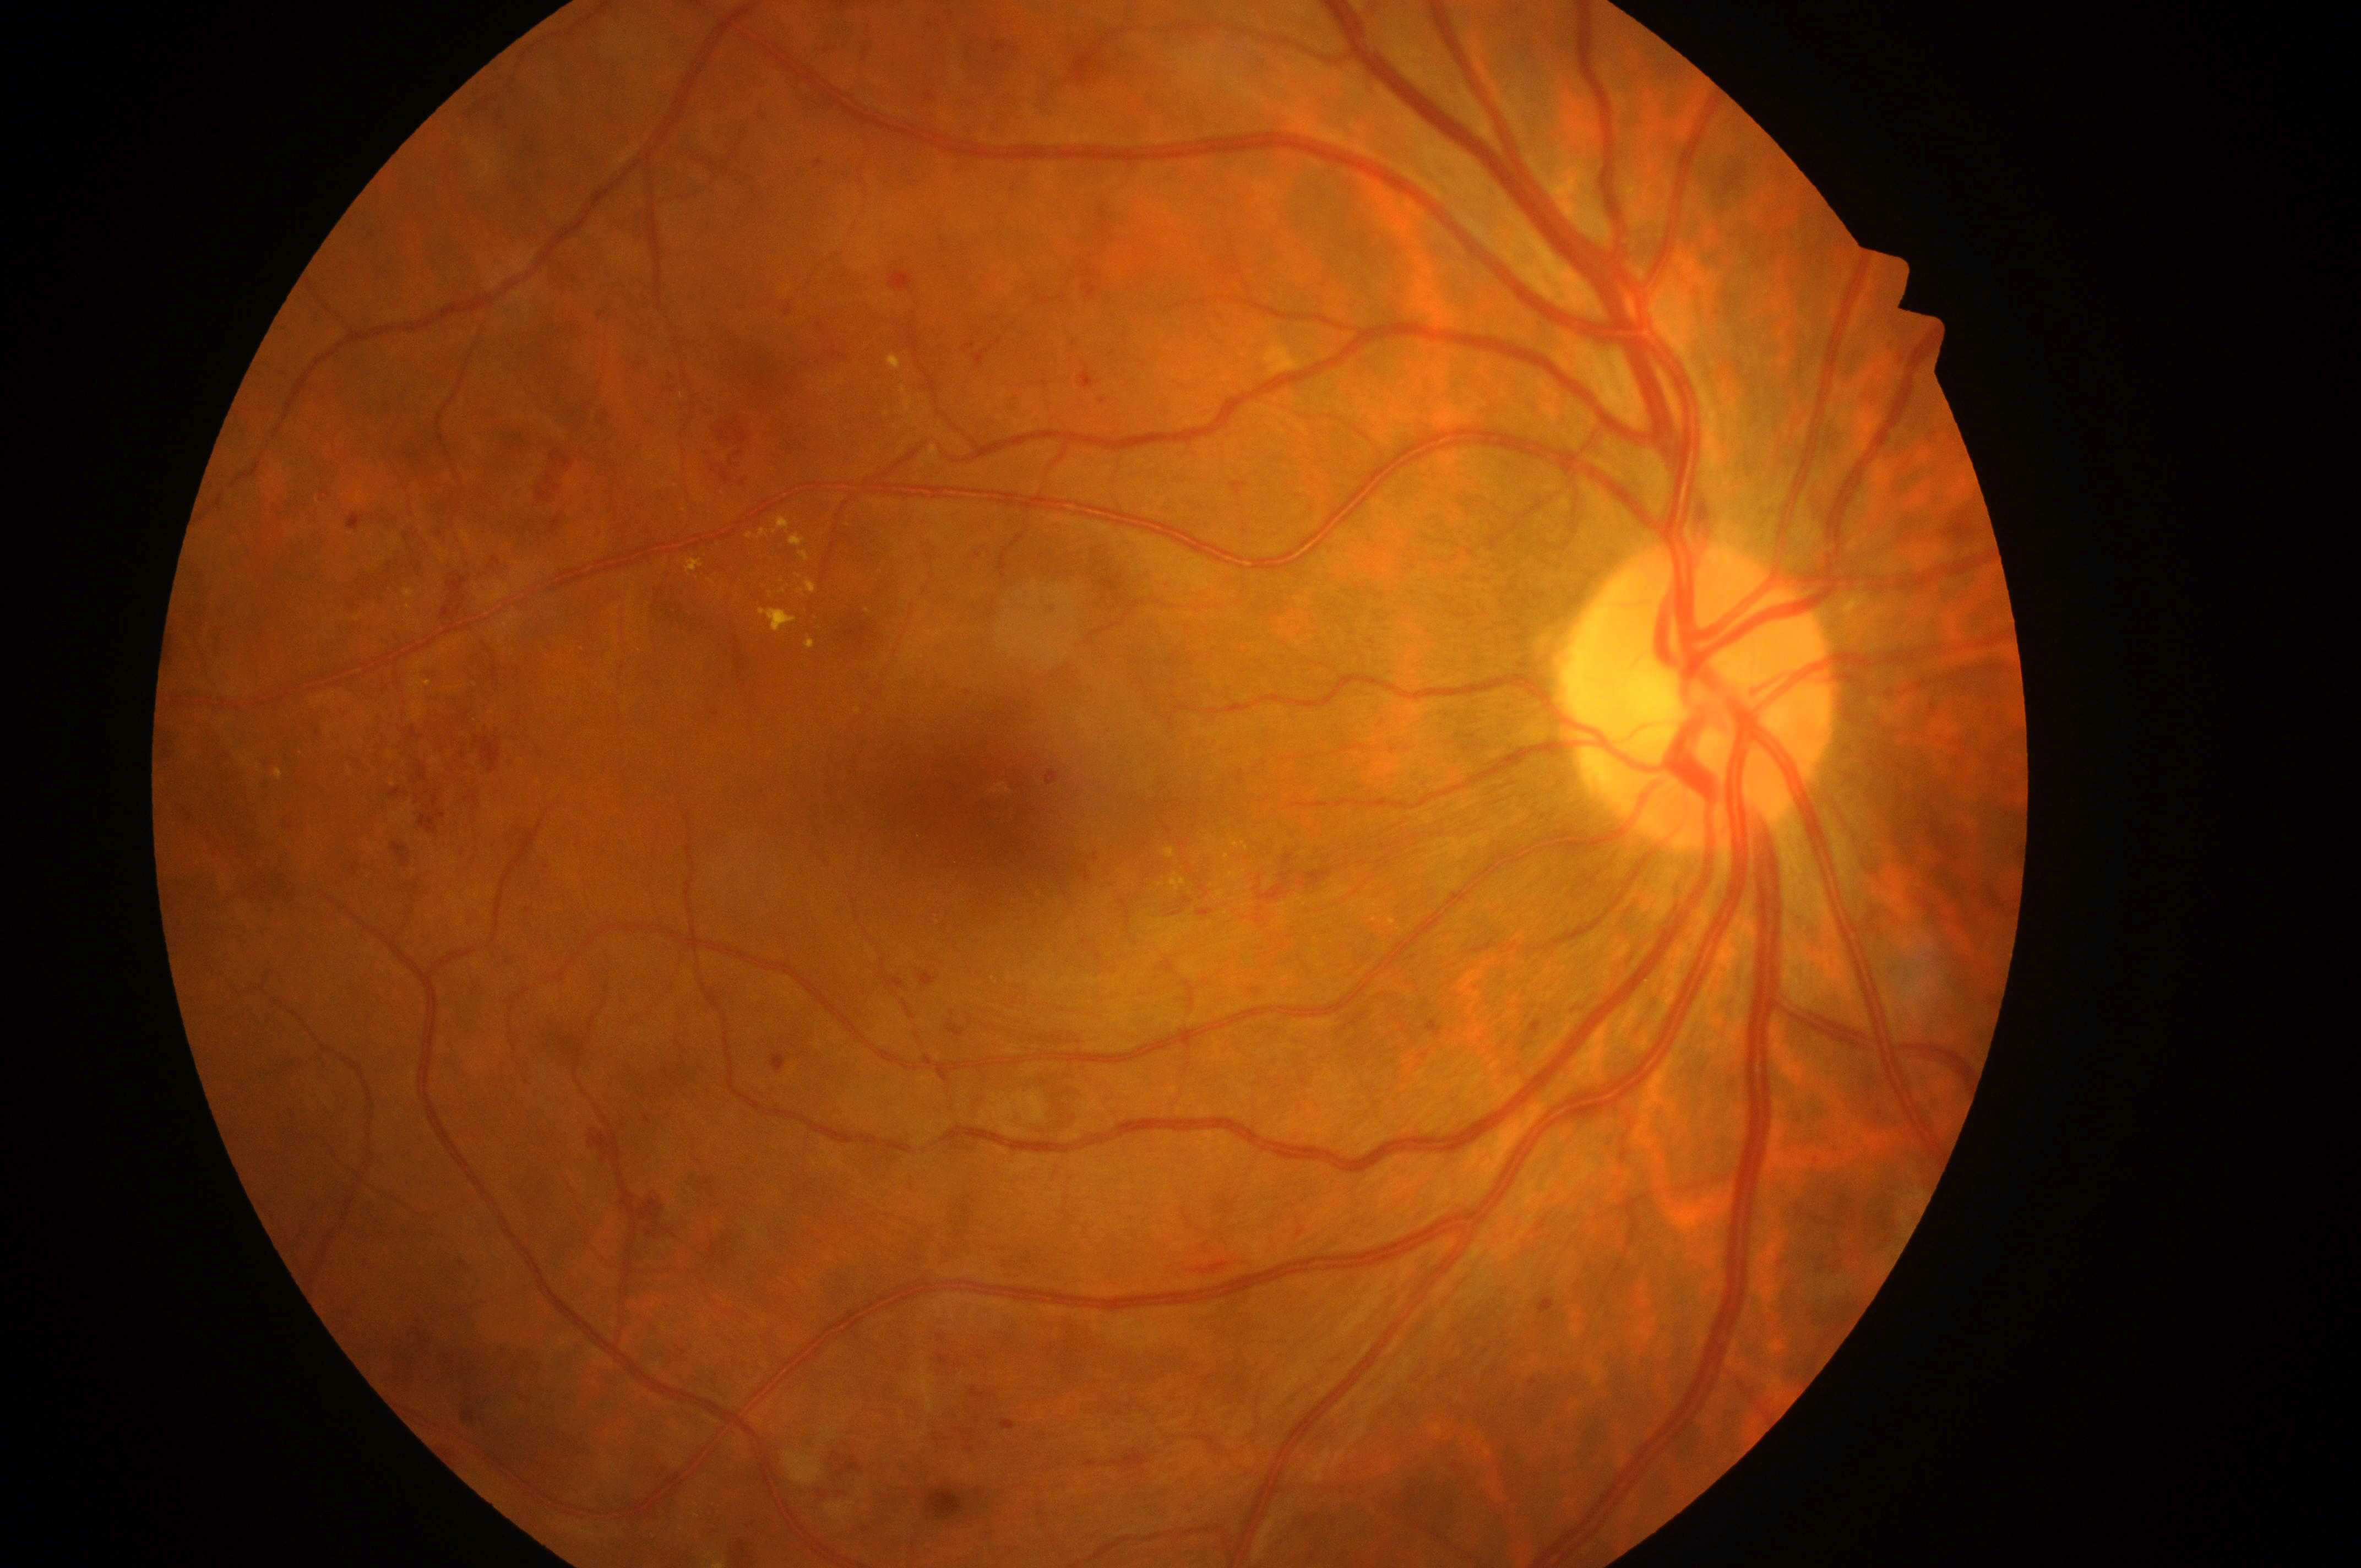 Fovea located at (x=986, y=812). Imaged eye: the right eye. DME is grade 2. DR grade is 3. The ONH is at (x=1706, y=701).